Retinal fundus photograph
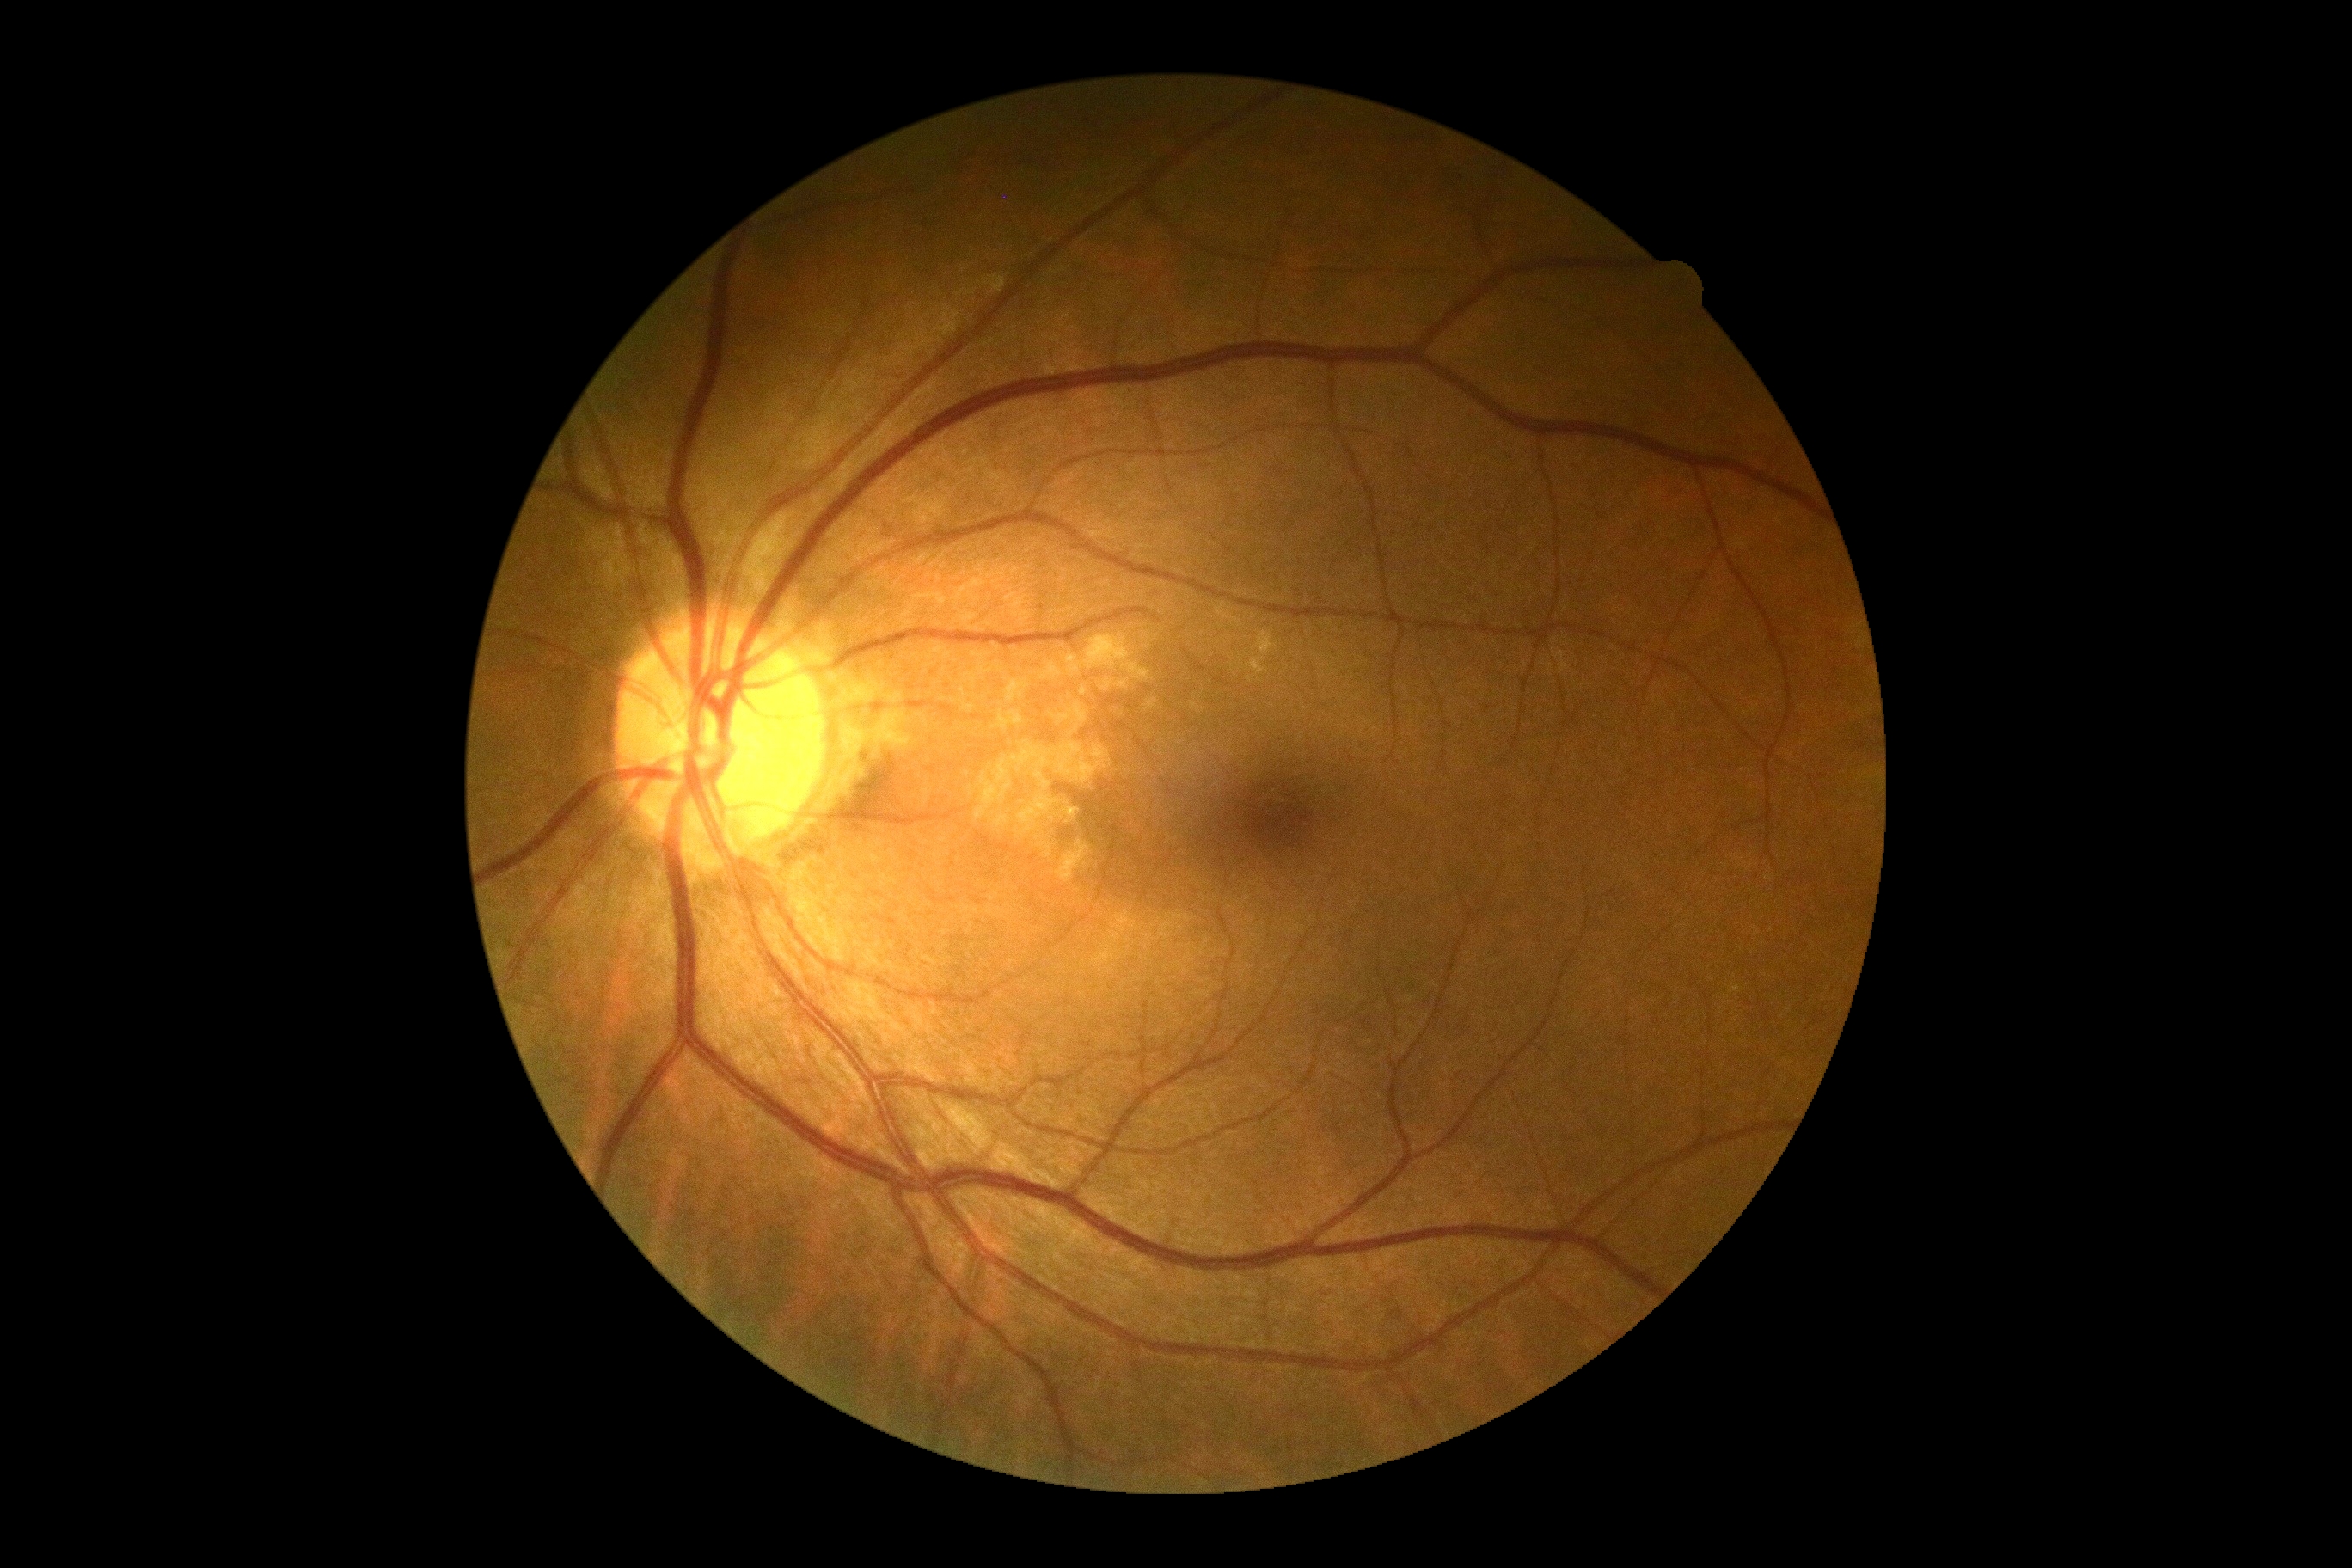
Diabetic retinopathy (DR) is no apparent diabetic retinopathy (grade 0).